130° field of view (Clarity RetCam 3); wide-field fundus image from infant ROP screening — 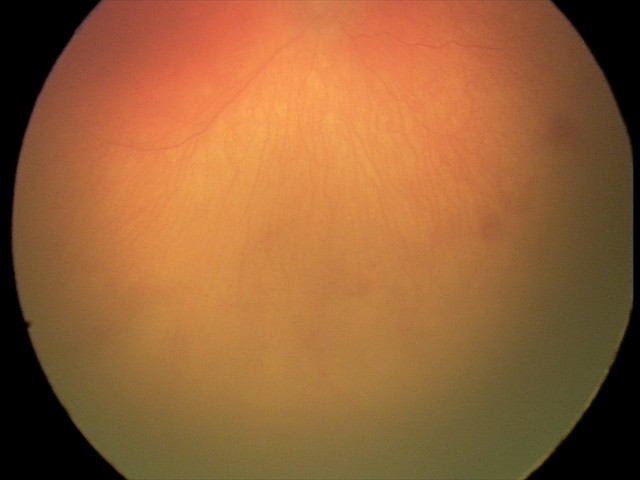

Screening: aggressive retinopathy of prematurity.